45-degree field of view, NIDEK AFC-230
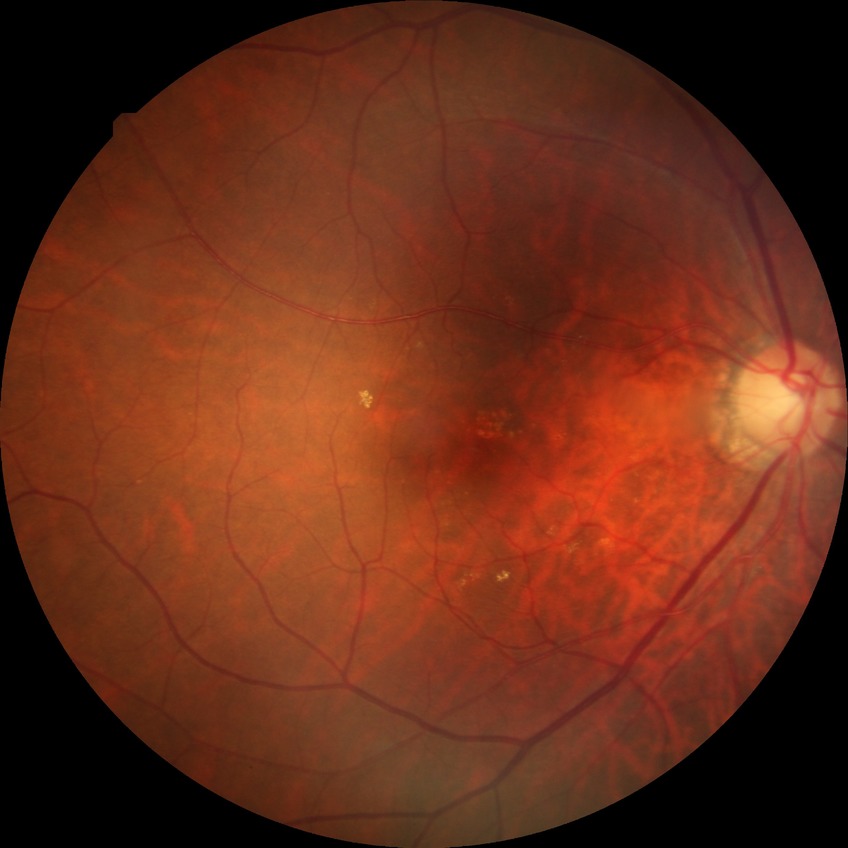

DR impression = no signs of DR | Davis grade = NDR.